Wide-field contact fundus photograph of an infant. Acquired on the Phoenix ICON — 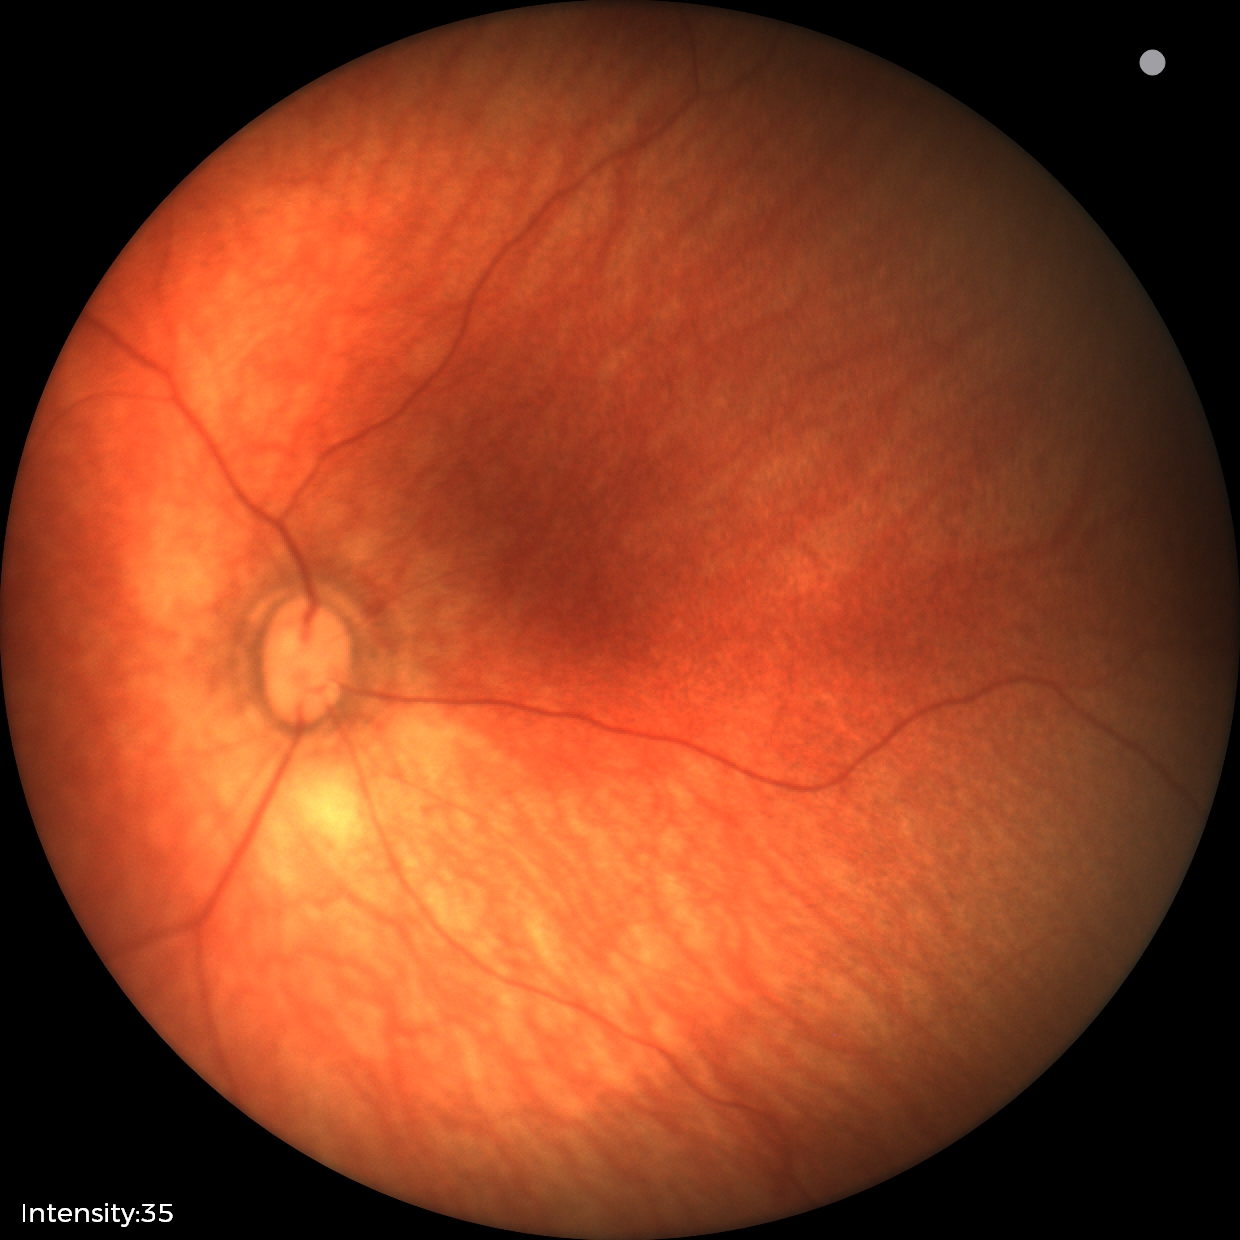 Screening diagnosis: normal fundus examination.